Graded on the modified Davis scale.
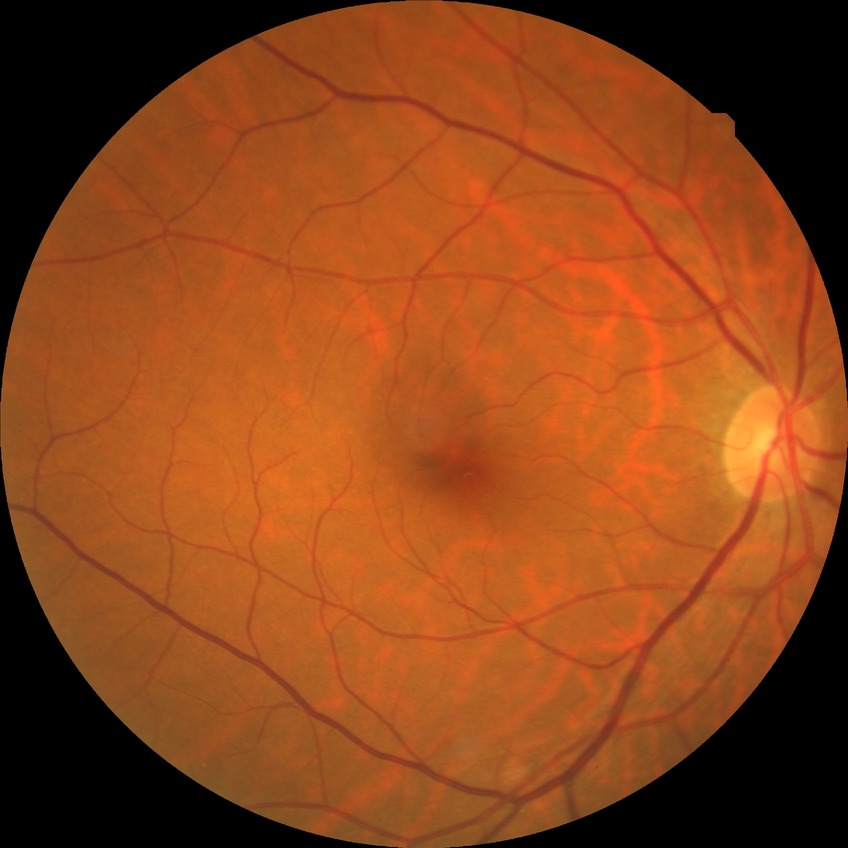 Diabetic retinopathy (DR) is no diabetic retinopathy (NDR).